CFP · 2048 x 1536 pixels · 45° field of view: 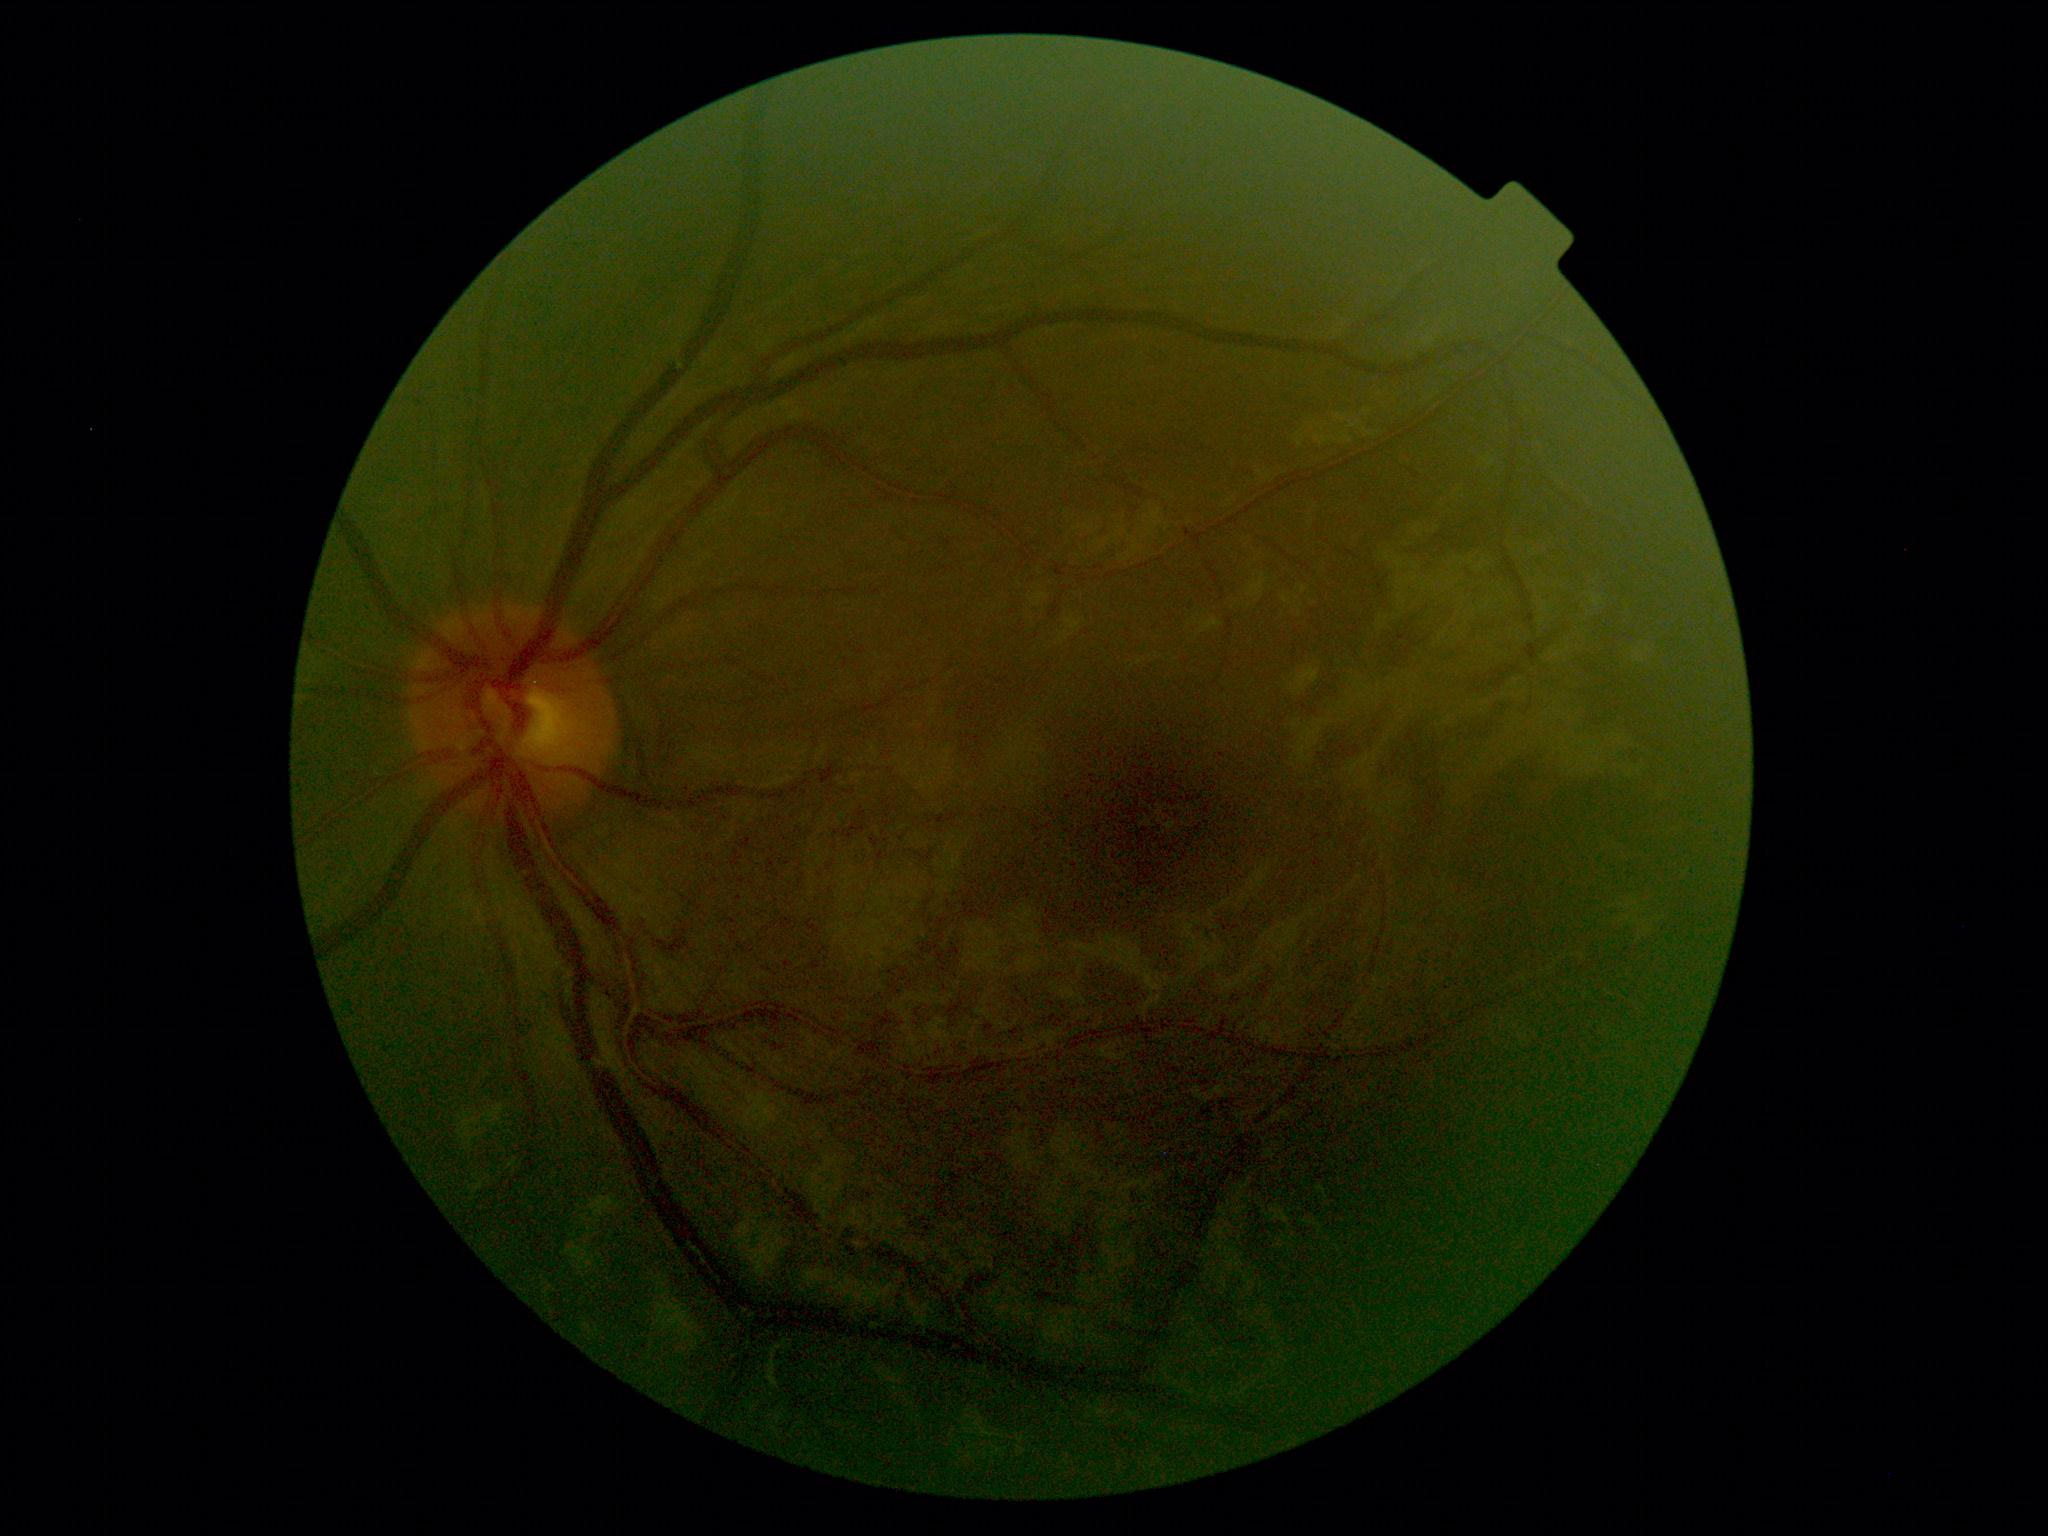   dr_grade: grade 0 (no apparent retinopathy)
  dr_impression: no apparent DR